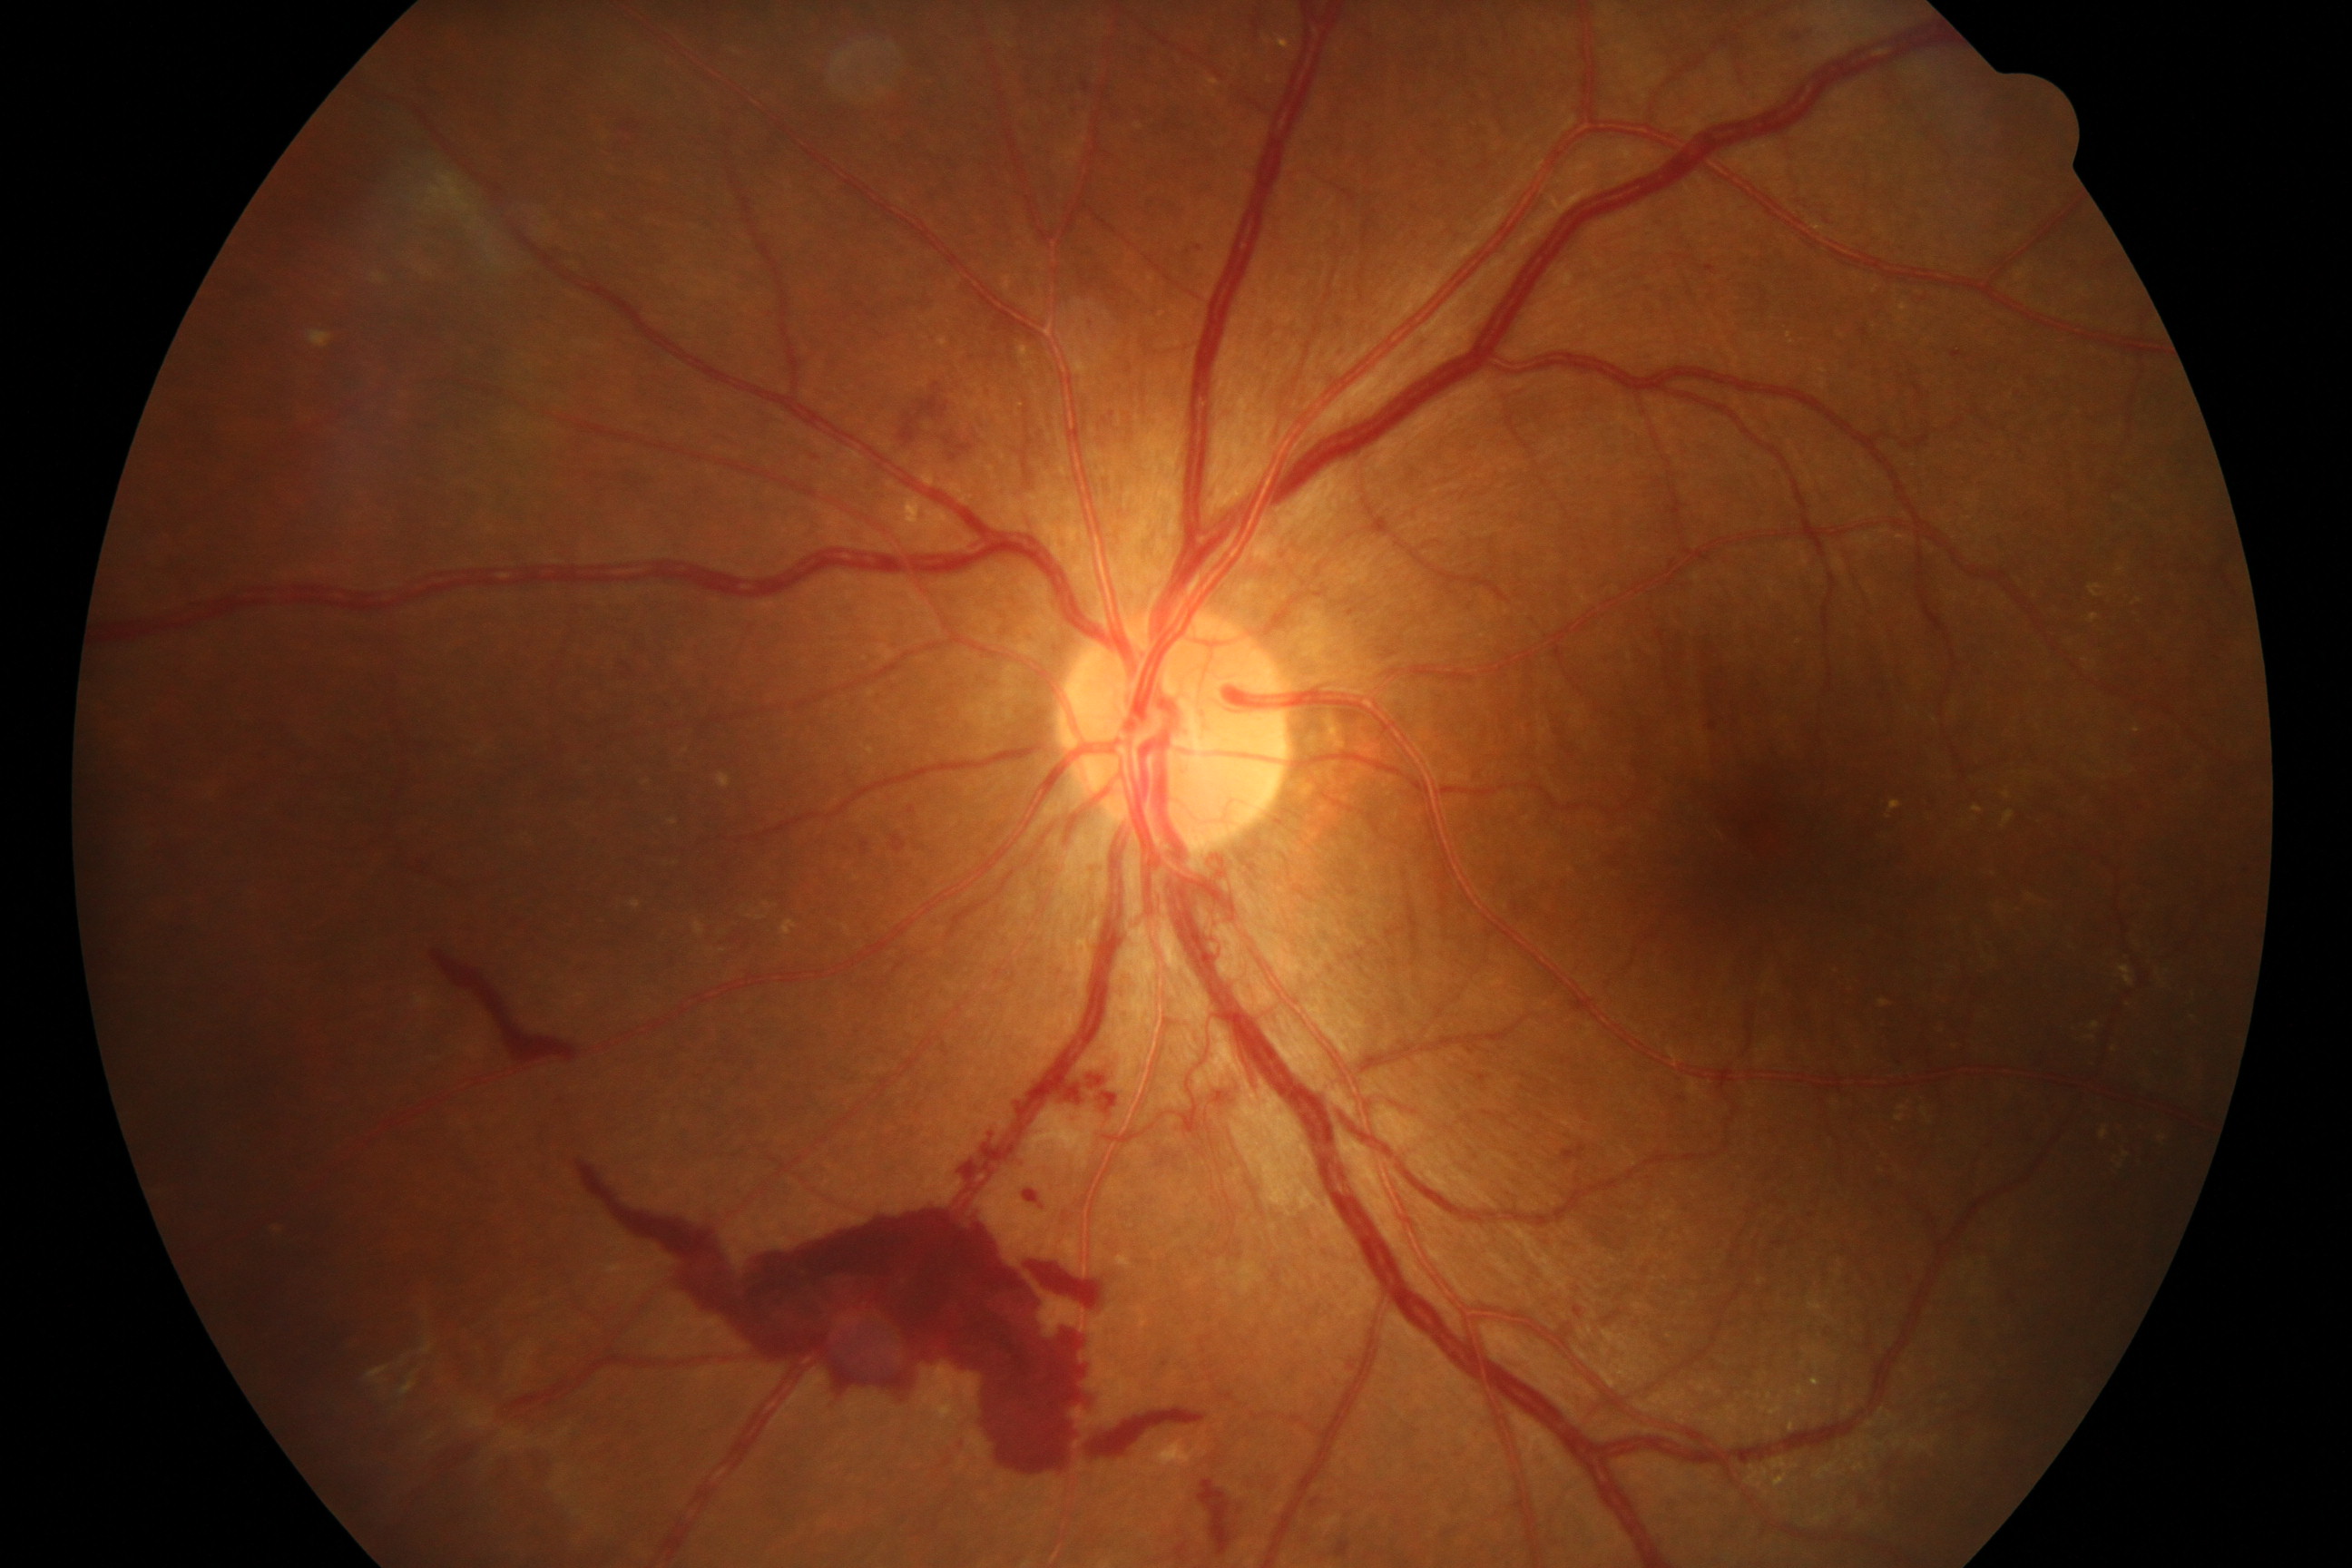 Consistent with severe non-proliferative or proliferative diabetic retinopathy.